Color fundus photograph
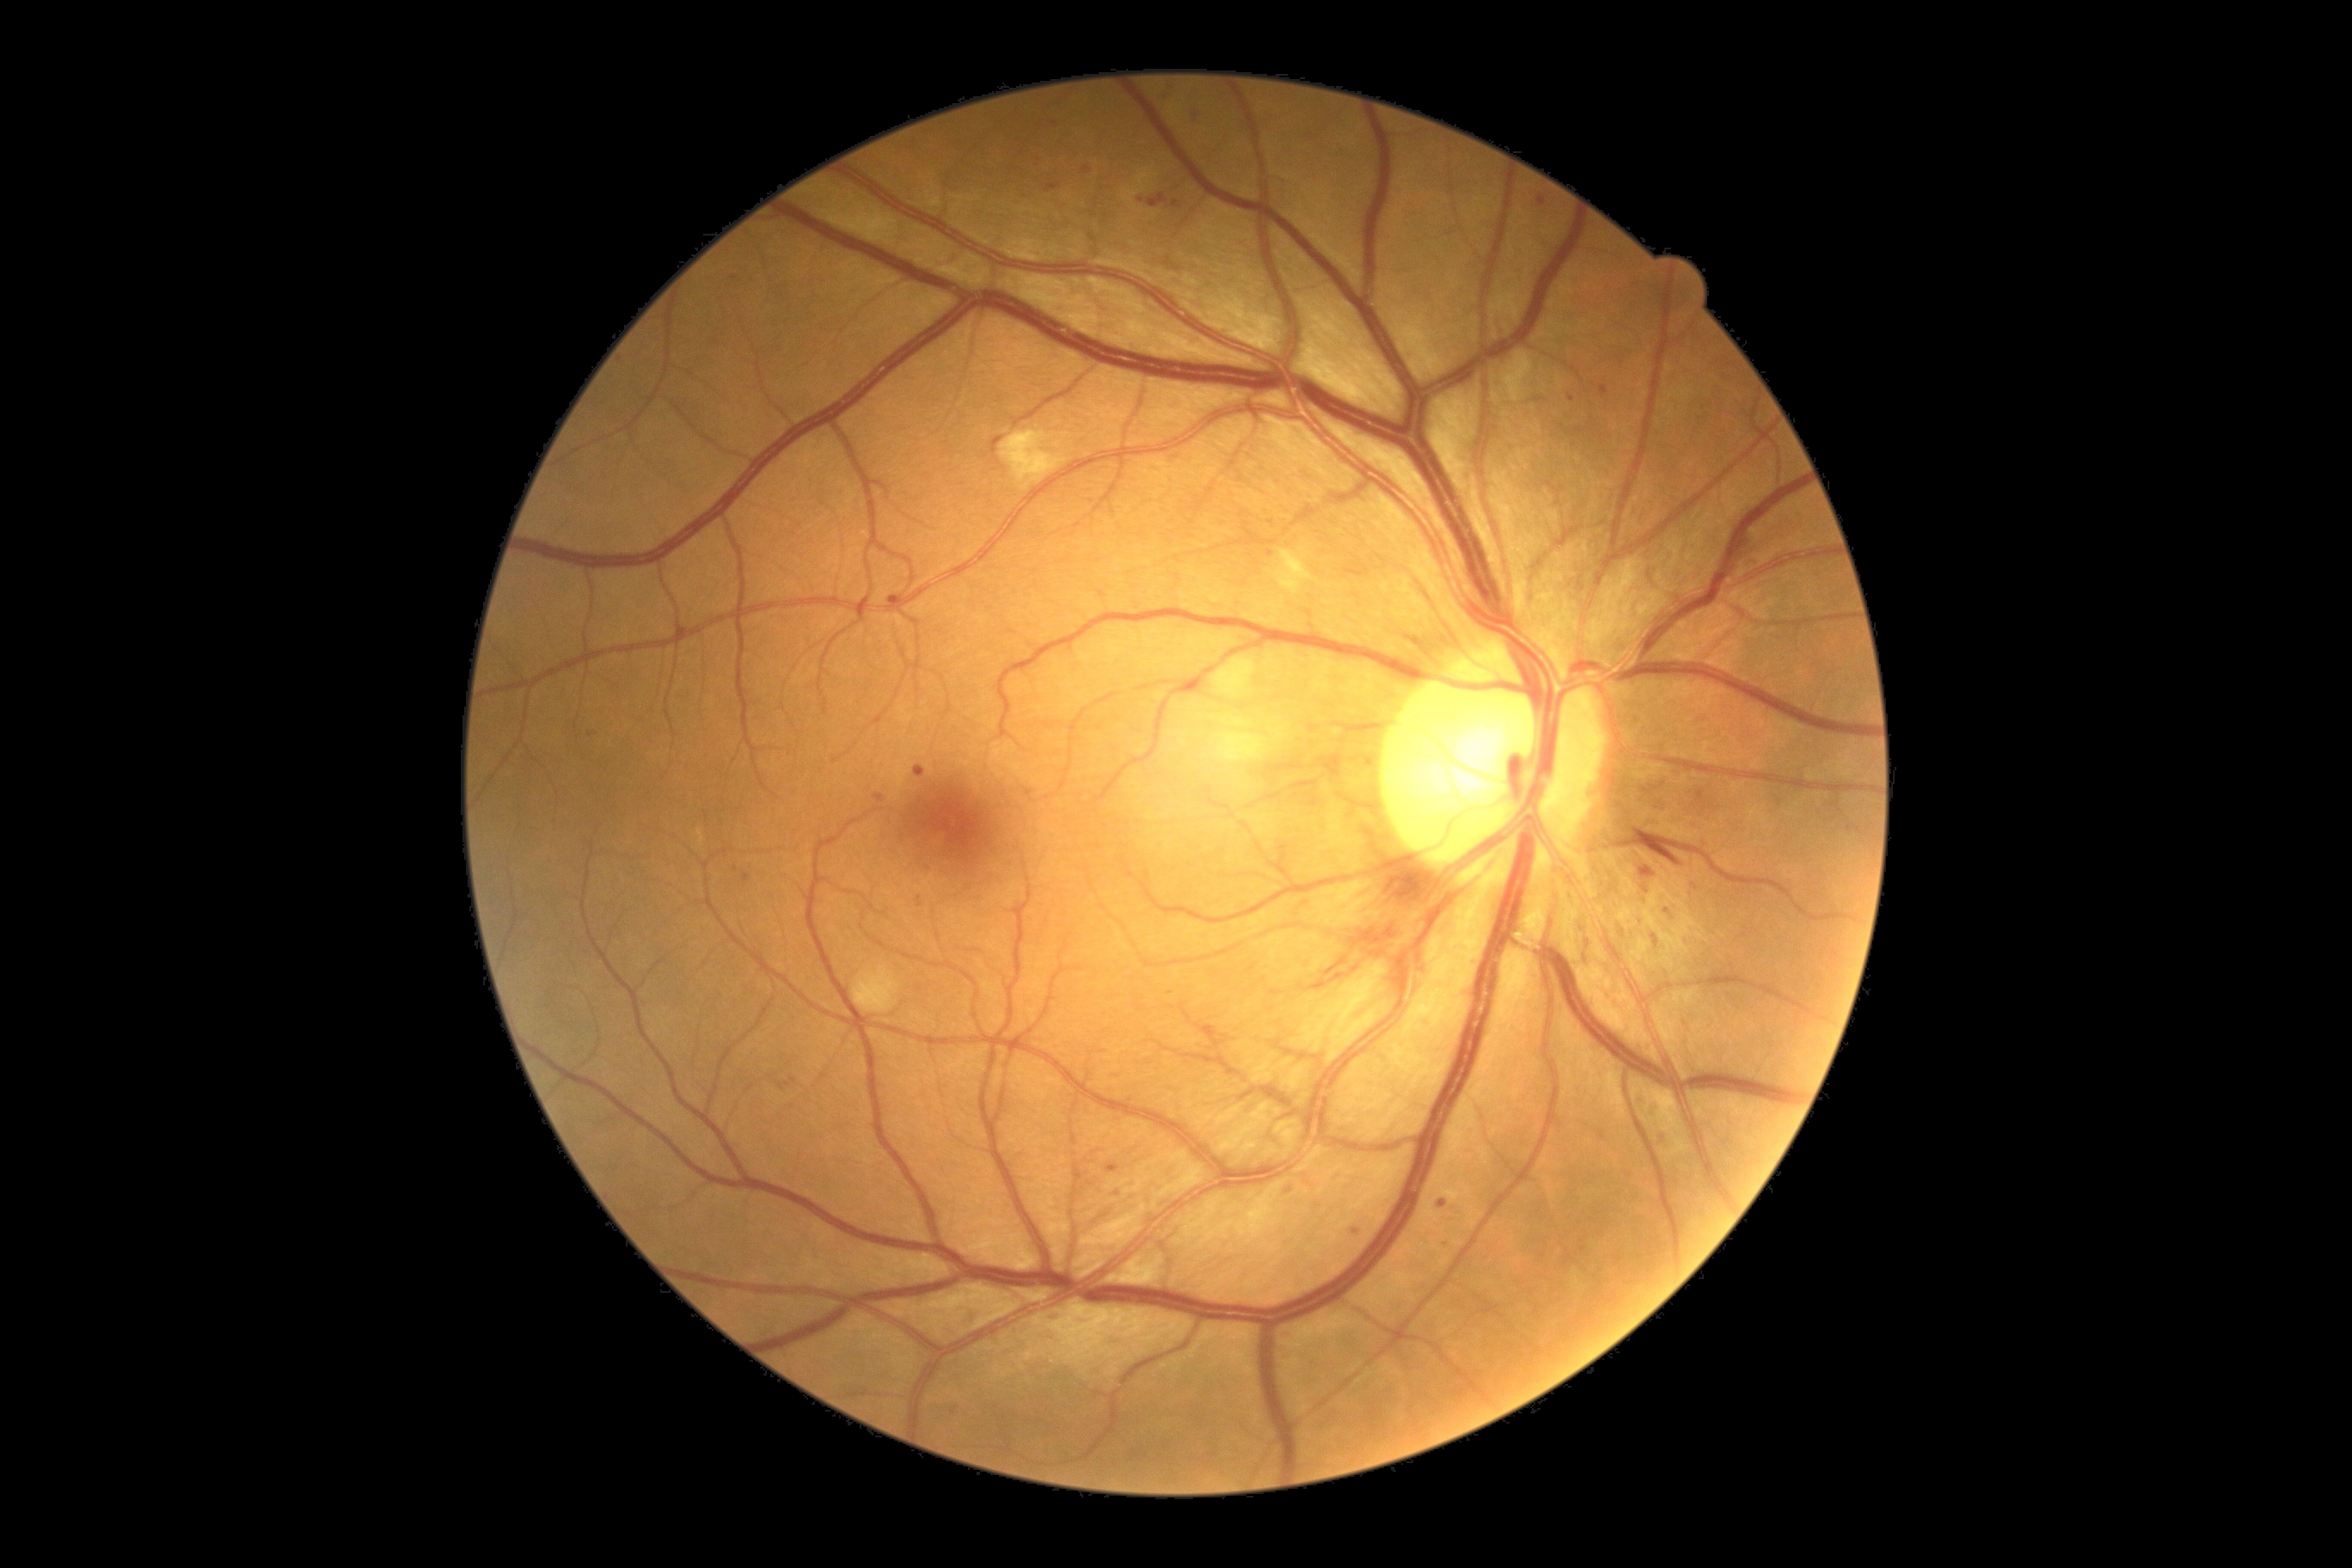
<lesions partial="true">
  <dr_grade>2</dr_grade>
  <ex />
  <ma partial="true">bbox=(589, 732, 597, 738) | bbox=(1653, 936, 1660, 945) | bbox=(1660, 1134, 1669, 1144) | bbox=(991, 438, 1003, 456) | bbox=(1847, 826, 1861, 833) | bbox=(1366, 757, 1375, 768) | bbox=(1148, 193, 1168, 209) | bbox=(1746, 560, 1761, 570) | bbox=(1352, 1228, 1364, 1237) | bbox=(1693, 790, 1705, 807) | bbox=(1106, 1165, 1120, 1173)</ma>
  <ma_small><point>1663, 785</point> | <point>1572, 399</point> | <point>1834, 804</point> | <point>1029, 793</point> | <point>1667, 912</point> | <point>1271, 553</point> | <point>1117, 1193</point></ma_small>
  <he>bbox=(1299, 864, 1447, 1017) | bbox=(1632, 828, 1655, 836) | bbox=(1648, 848, 1682, 867)</he>
  <se>bbox=(1213, 658, 1258, 697) | bbox=(1215, 732, 1268, 763) | bbox=(1034, 1304, 1192, 1364) | bbox=(1268, 551, 1321, 596) | bbox=(854, 967, 900, 1014) | bbox=(1000, 431, 1069, 484)</se>
</lesions>